2350 x 1568 pixels, retinal fundus photograph
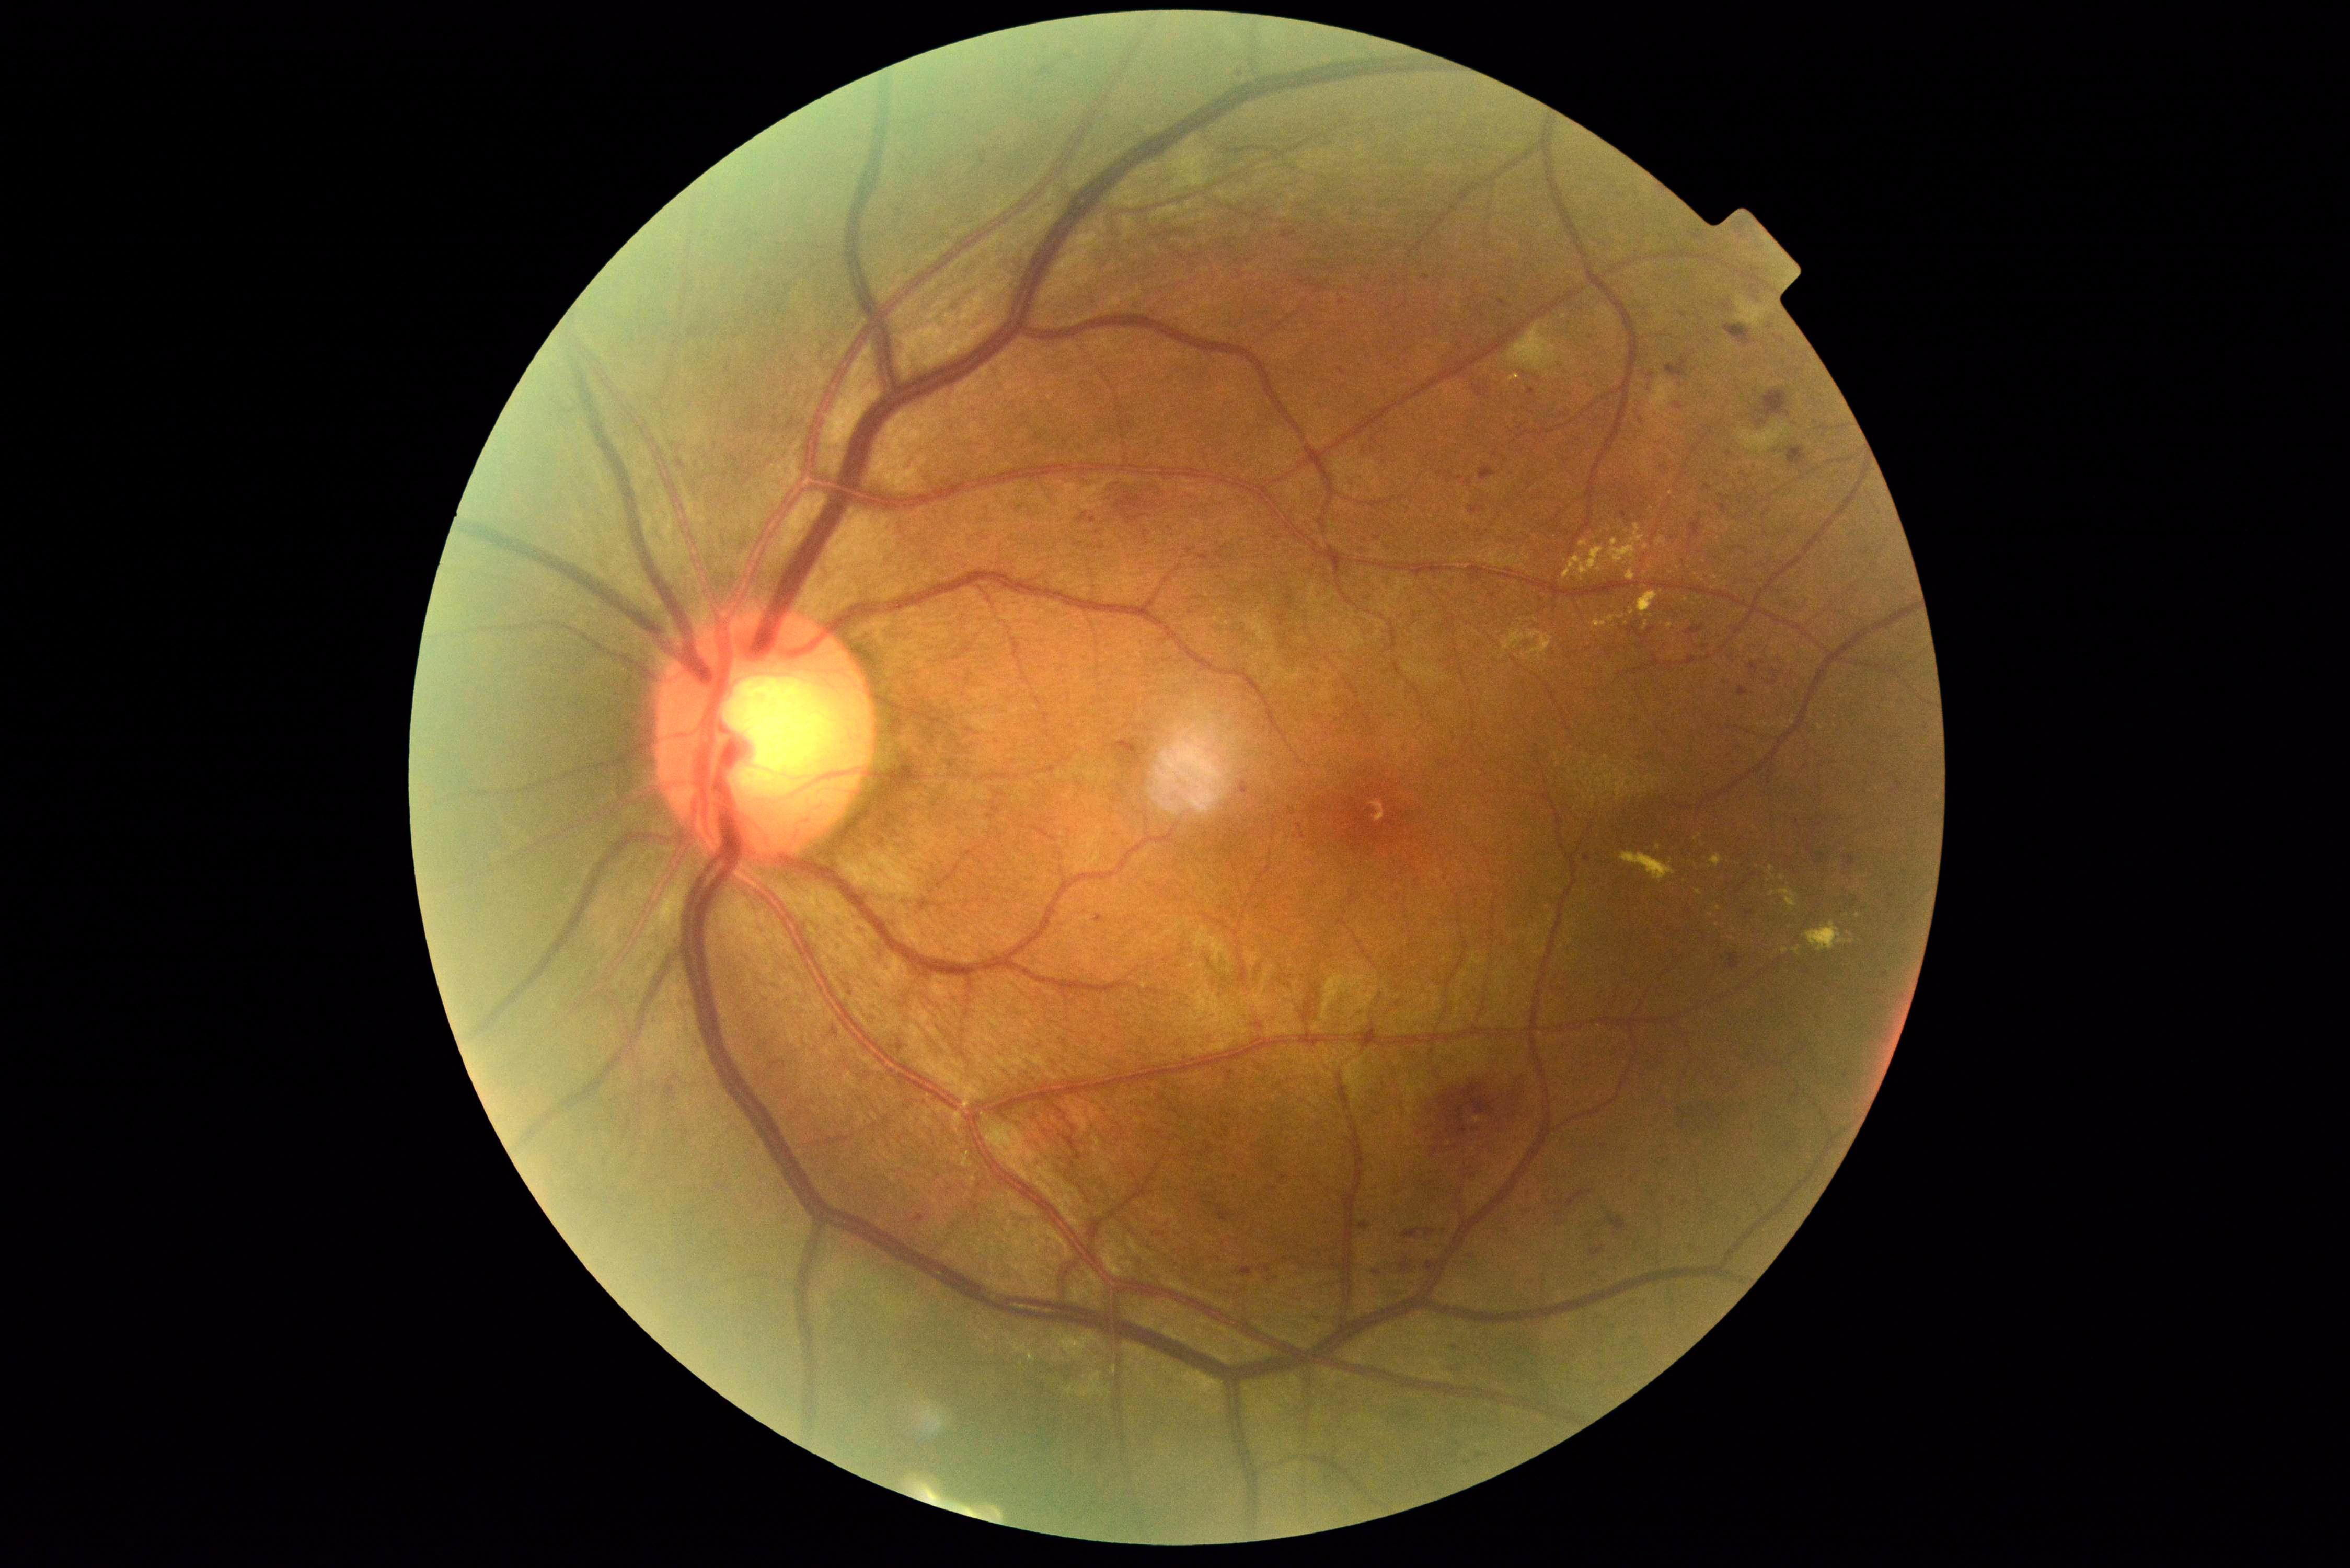
- DR stage — grade 3 (severe NPDR)